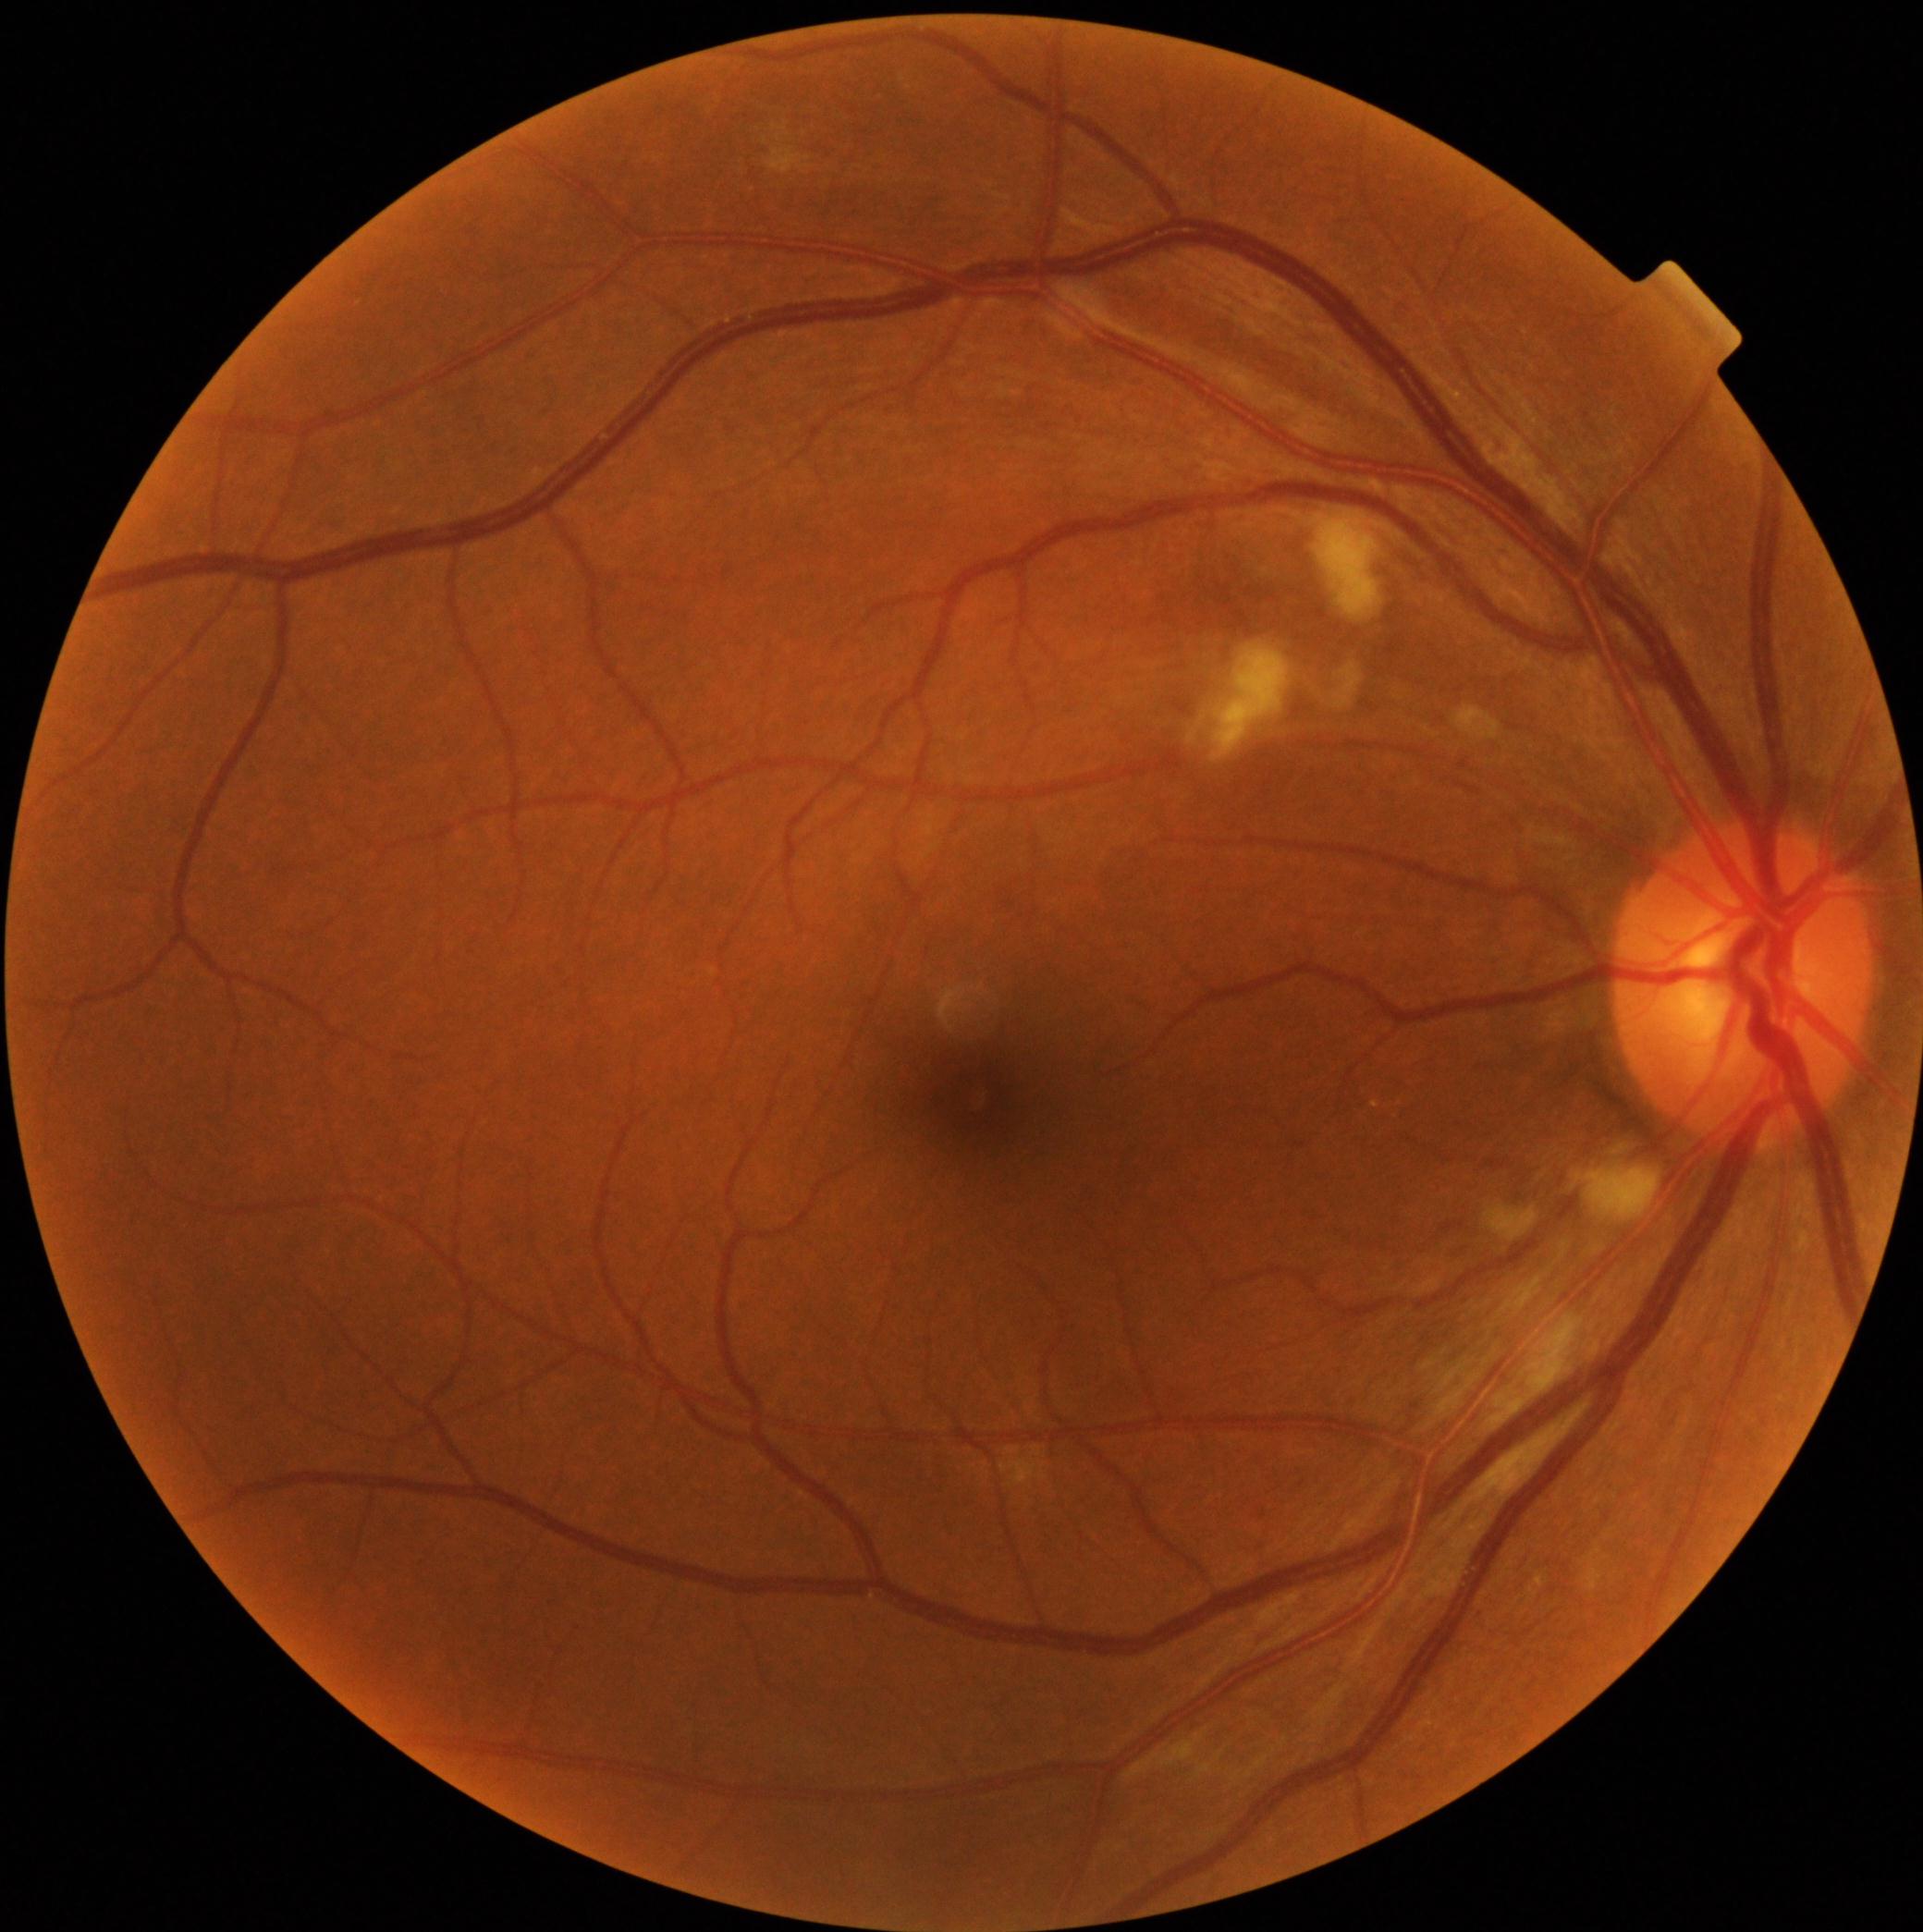
DR class: non-proliferative diabetic retinopathy. Diabetic retinopathy is moderate NPDR (grade 2).